Posterior pole photograph · modified Davis classification
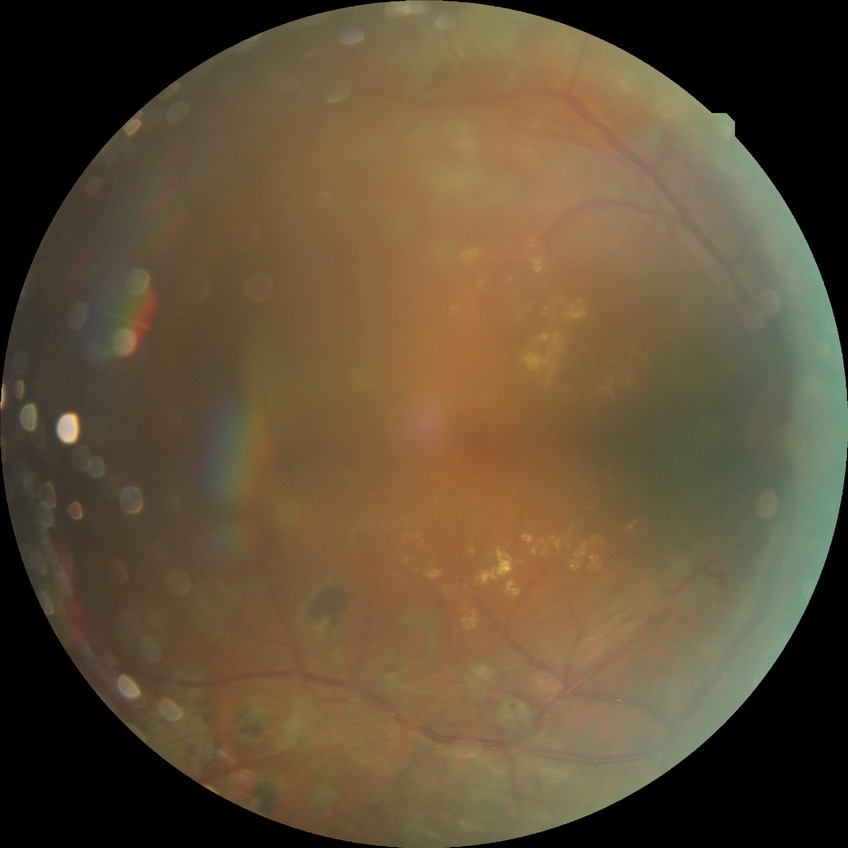 Modified Davis classification is proliferative diabetic retinopathy.